45 degree fundus photograph, NIDEK AFC-230 fundus camera: 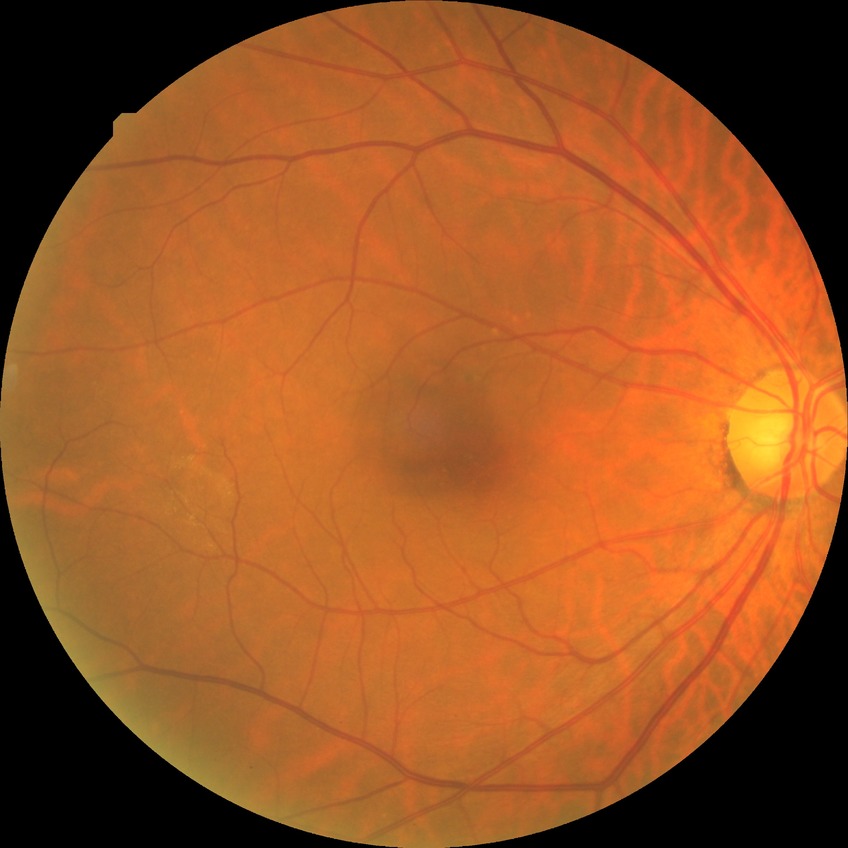

diabetic retinopathy (DR)=no diabetic retinopathy (NDR).